2352 x 1568 pixels · FOV: 45 degrees · color fundus image: 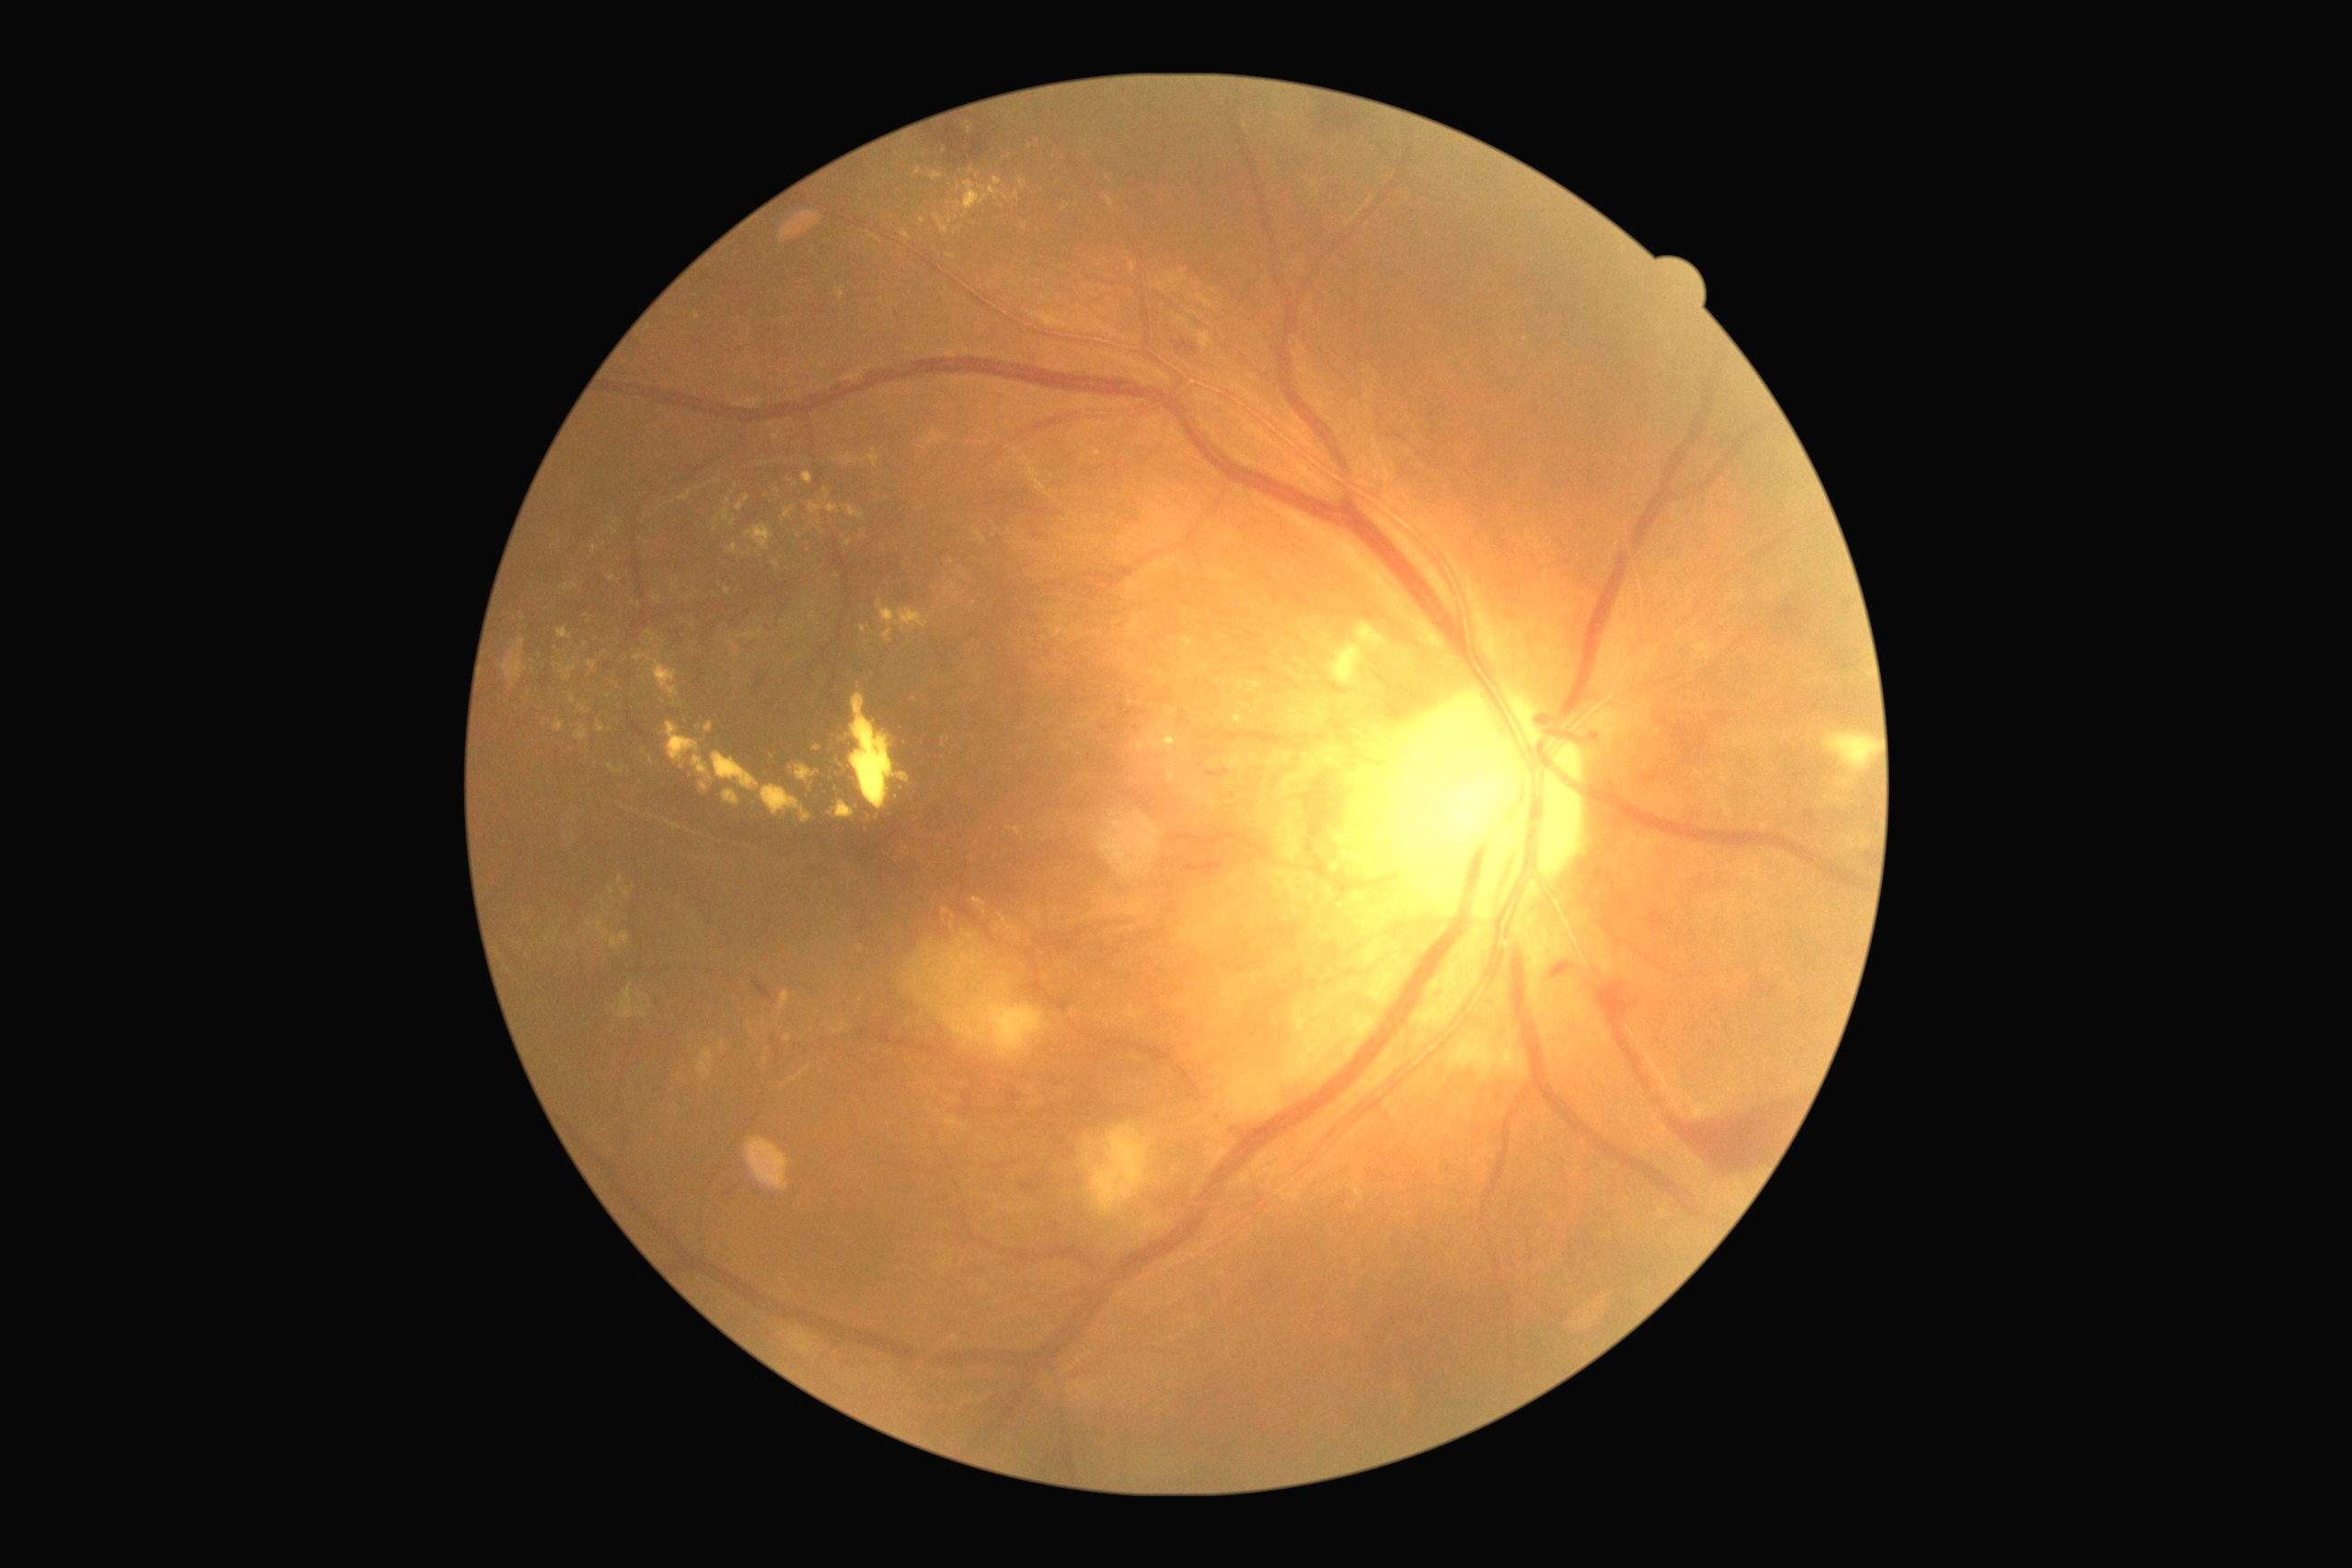
DR grade is 4 (PDR). EXs (partial list) at l=781, t=507, r=796, b=520; l=587, t=662, r=600, b=674; l=845, t=505, r=865, b=518; l=569, t=692, r=576, b=705; l=647, t=631, r=654, b=645; l=1182, t=638, r=1197, b=647; l=828, t=801, r=856, b=819; l=861, t=627, r=870, b=634; l=1295, t=906, r=1302, b=917; l=618, t=876, r=623, b=885; l=611, t=934, r=631, b=950; l=712, t=752, r=761, b=792. EXs (small, approximate centers) near (x=765, y=1061); (x=603, y=903); (x=1025, y=227); (x=728, y=501); (x=922, y=221); (x=543, y=725).